Image size 240x240 · non-mydriatic fundus camera — 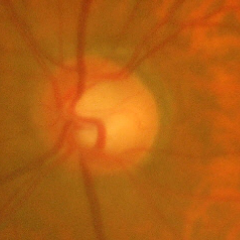 Diagnosis = advanced glaucoma.